Without pupil dilation: 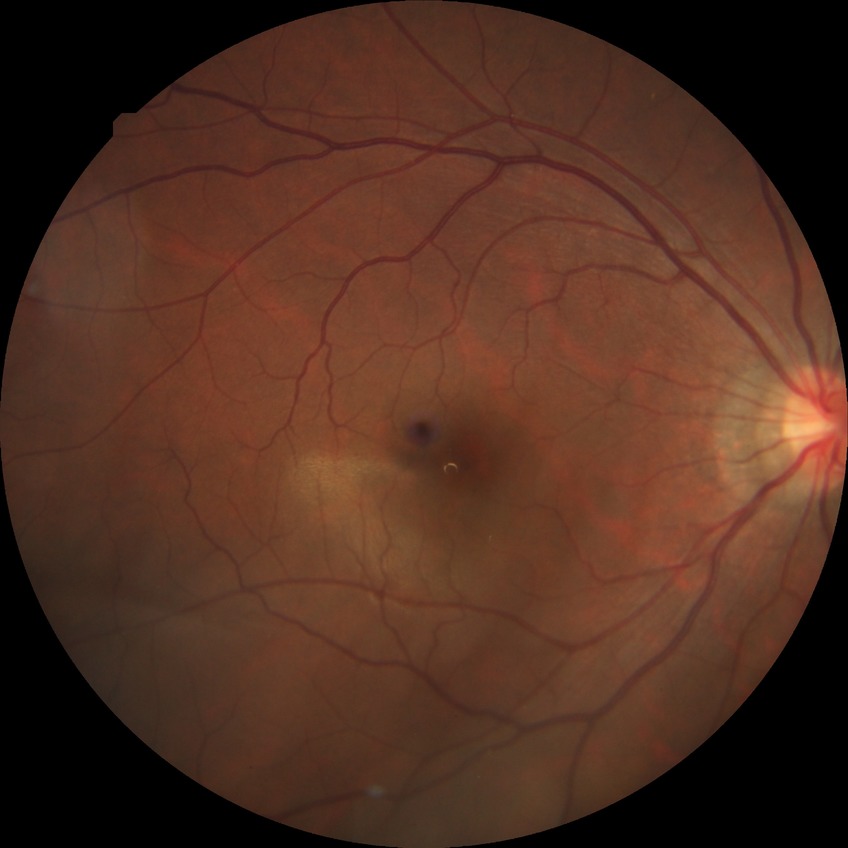
diabetic retinopathy (DR): NDR (no diabetic retinopathy).